Diabetic retinopathy graded by the modified Davis classification
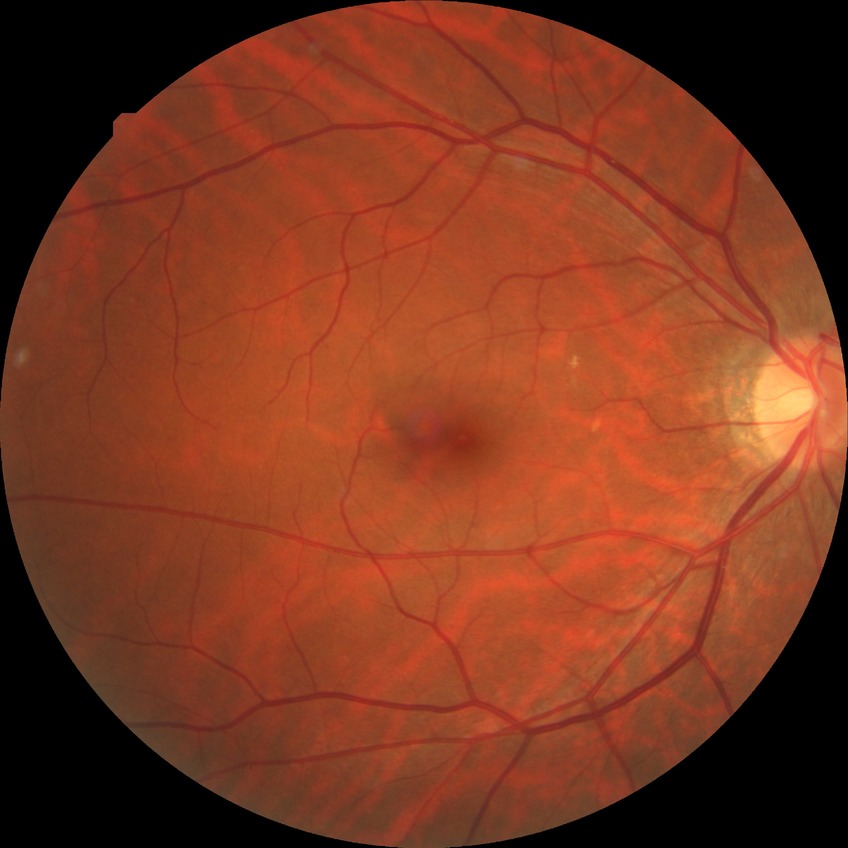 Diabetic retinopathy (DR): no diabetic retinopathy (NDR).